Camera: NIDEK AFC-230, modified Davis classification, without pupil dilation:
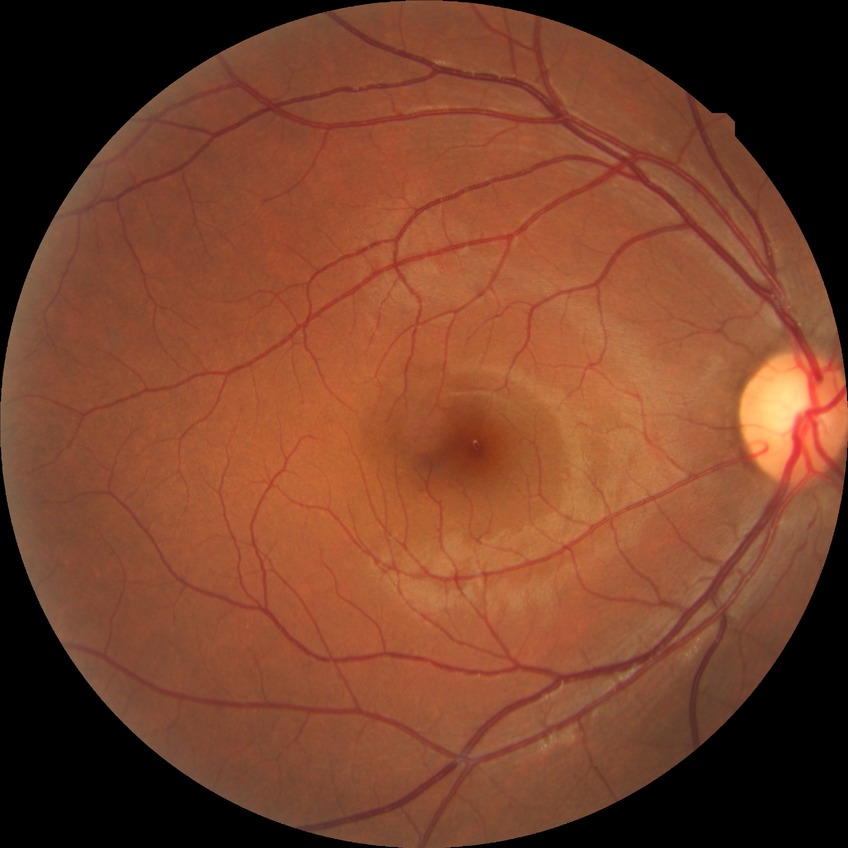 diabetic retinopathy severity@no diabetic retinopathy.